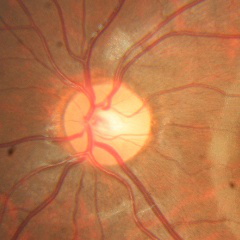 No signs of glaucoma.